Fundus photo — 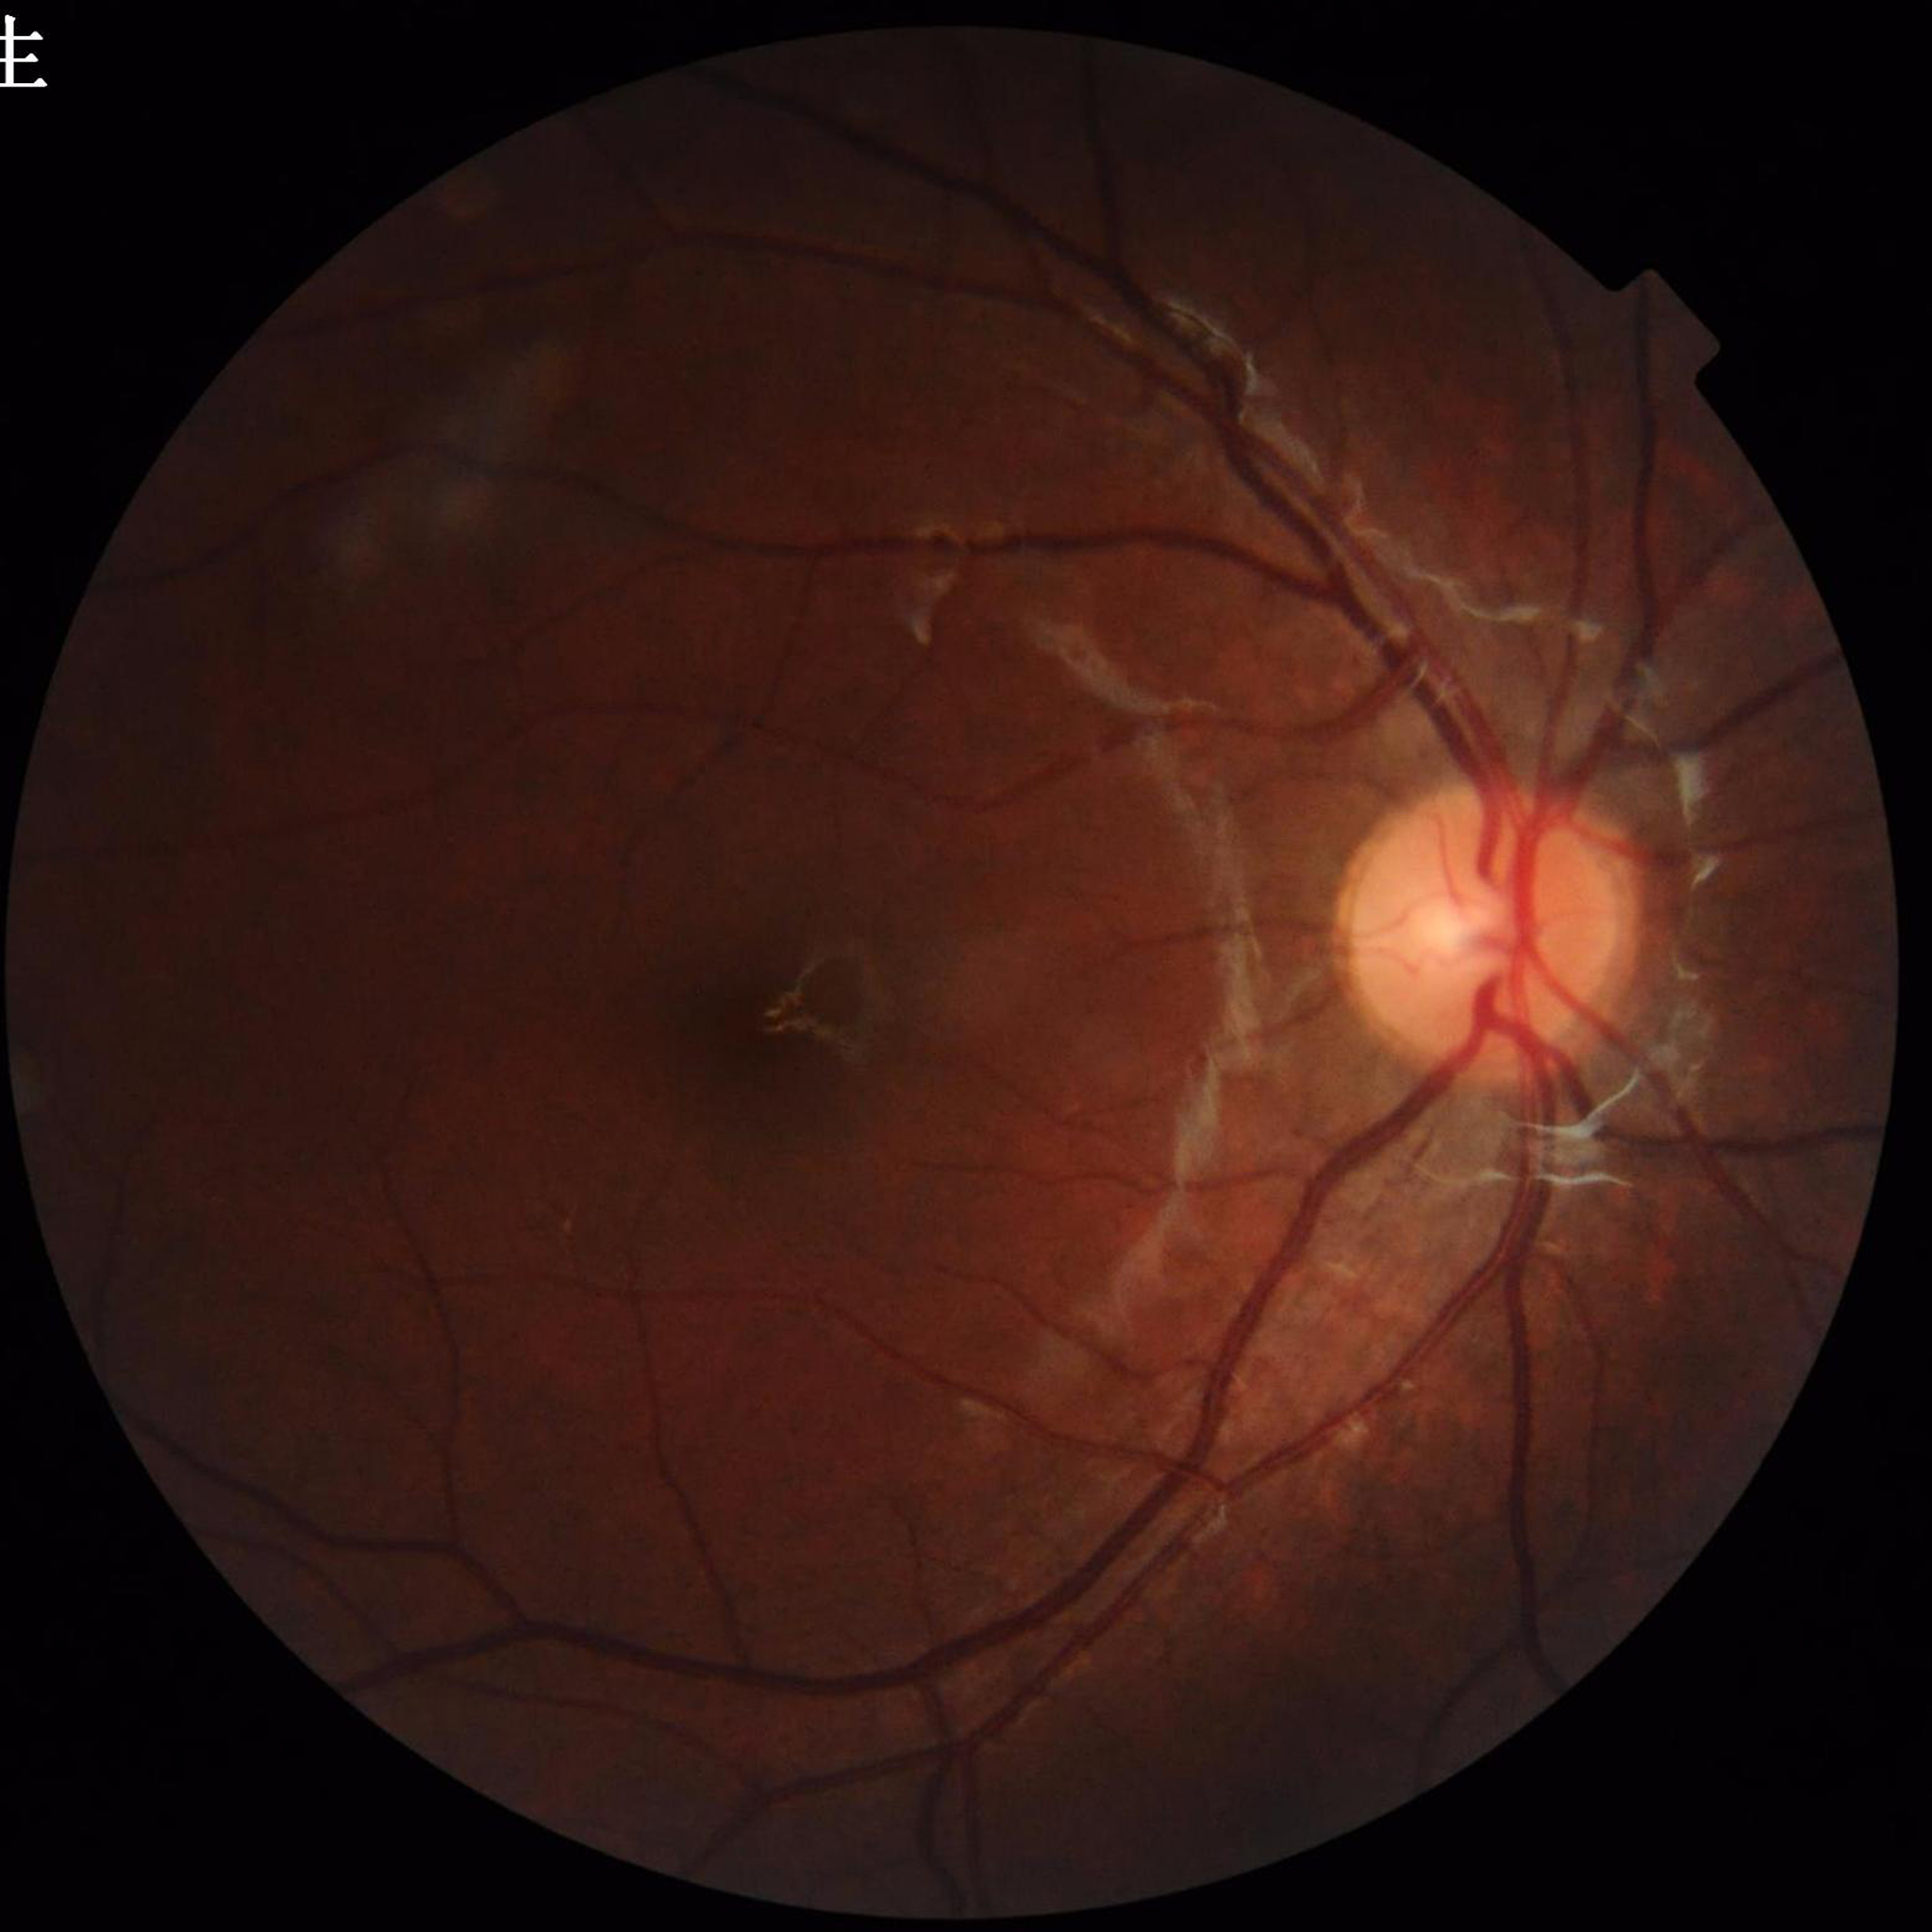

No signs of AMD, diabetic retinopathy, or glaucoma.